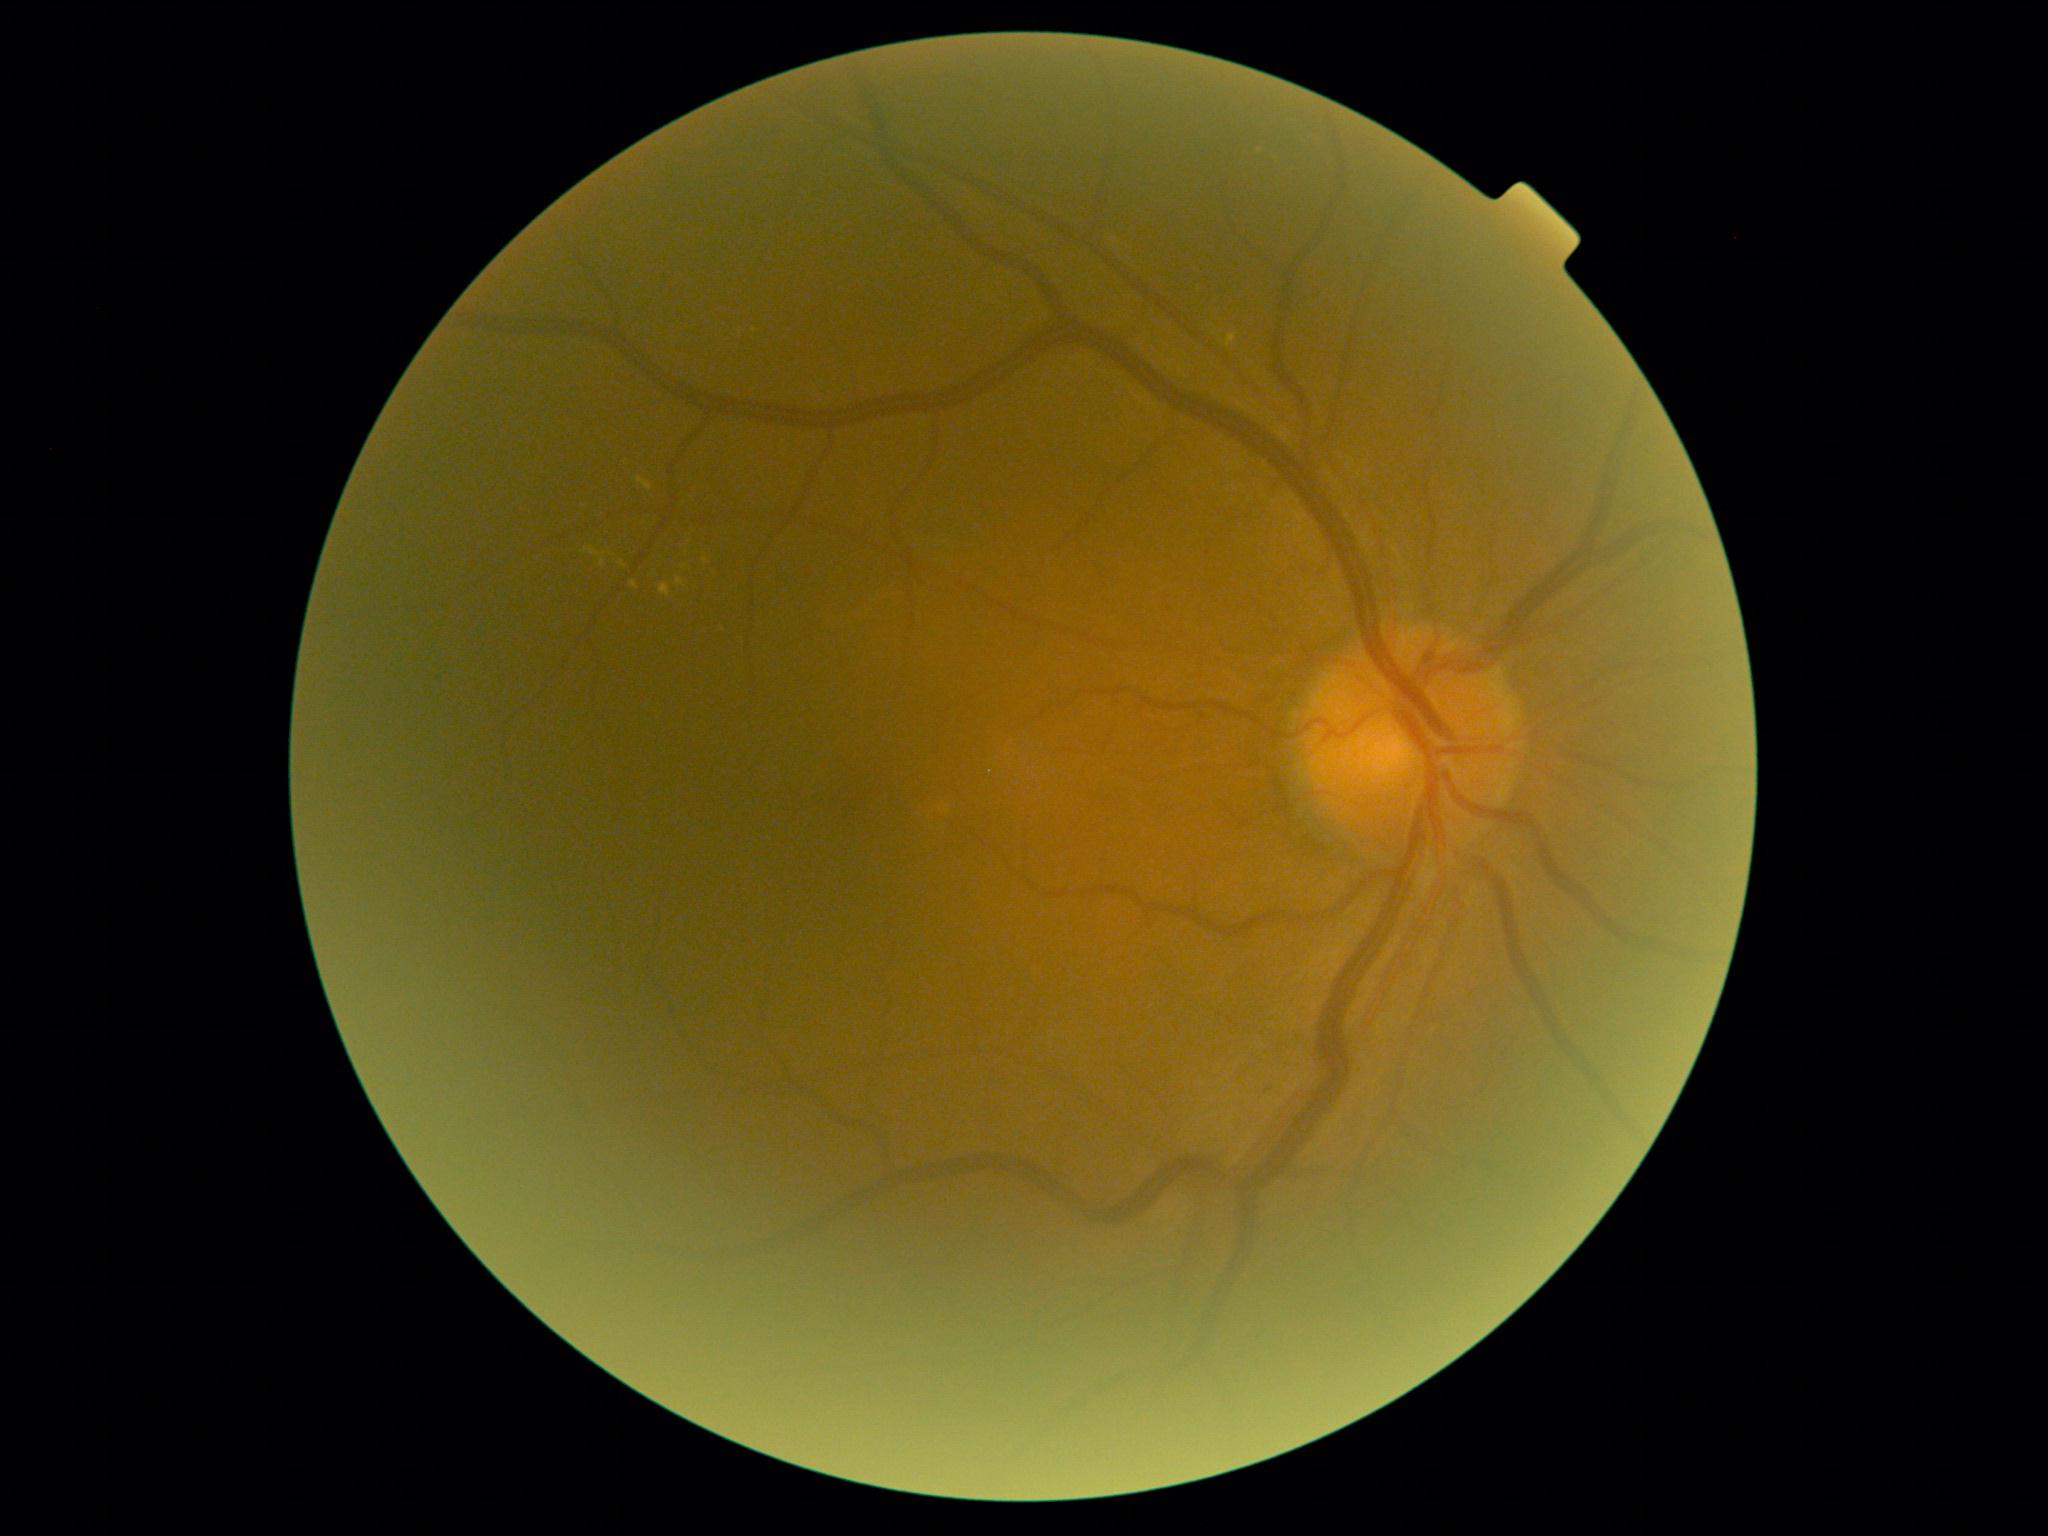

DR grade: 2/4.